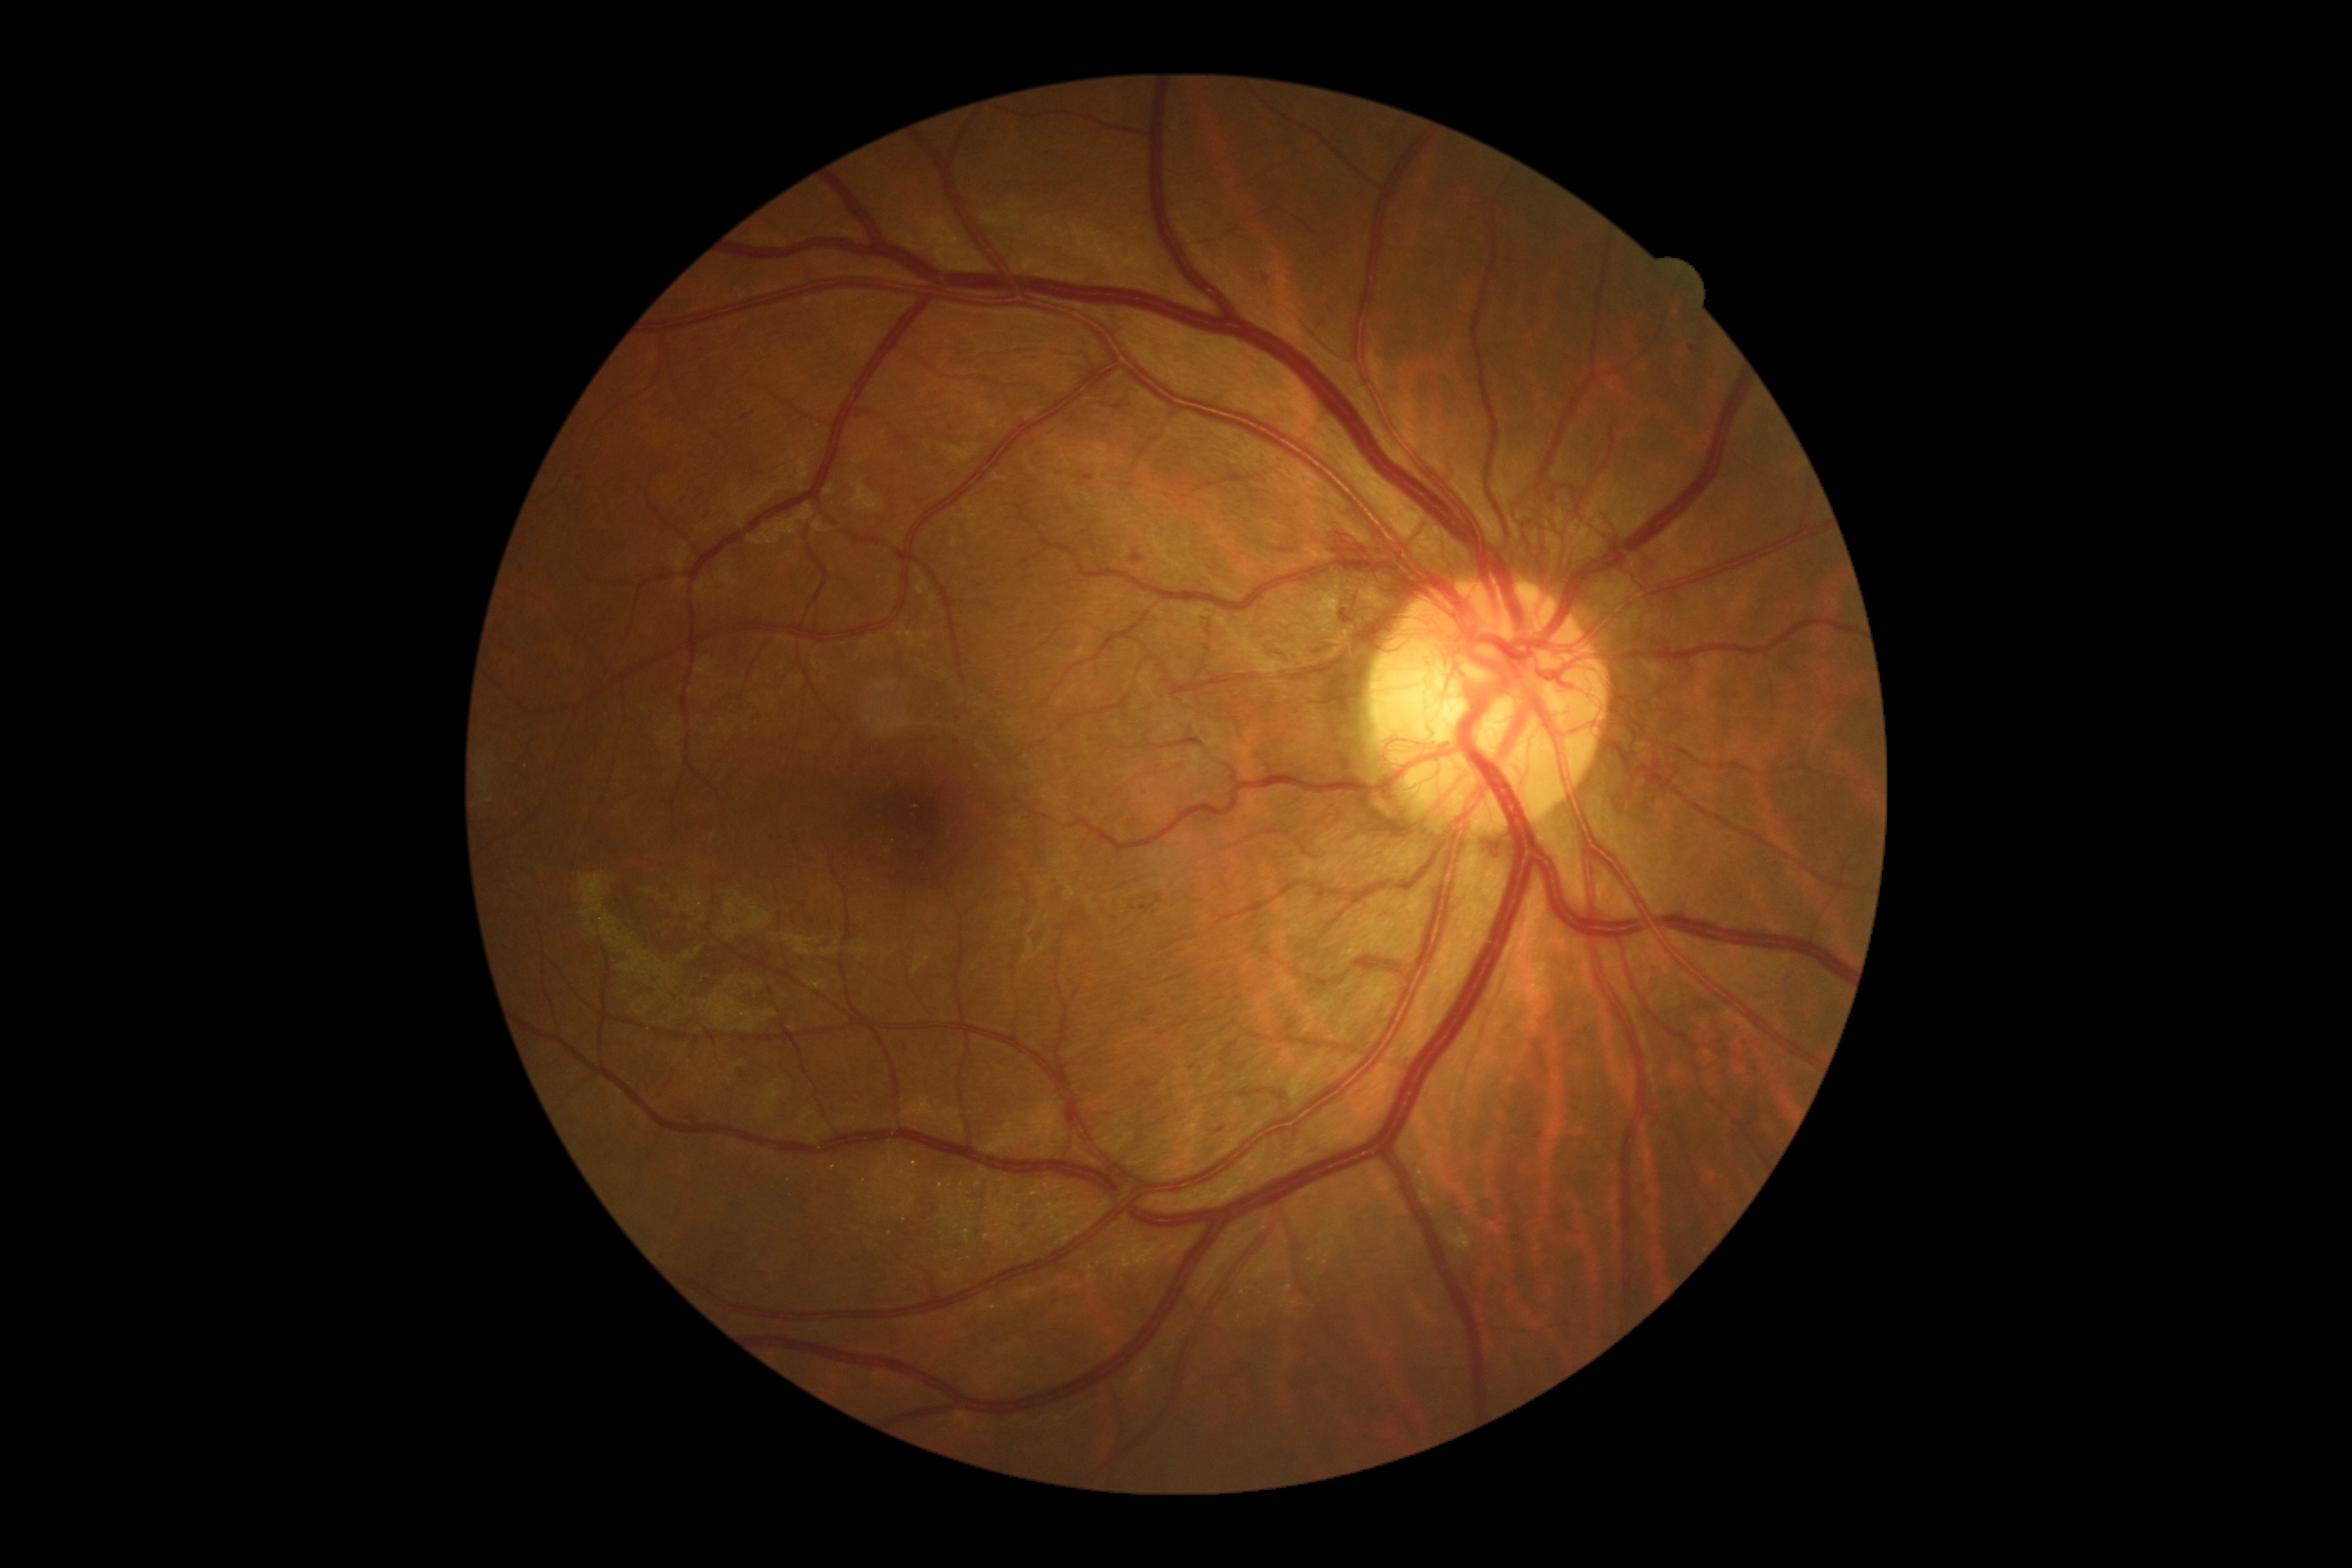 diabetic retinopathy (DR): 4/4.